Captured on a Remidio smartphone fundus camera. Retinal fundus photograph. 1659x2212.
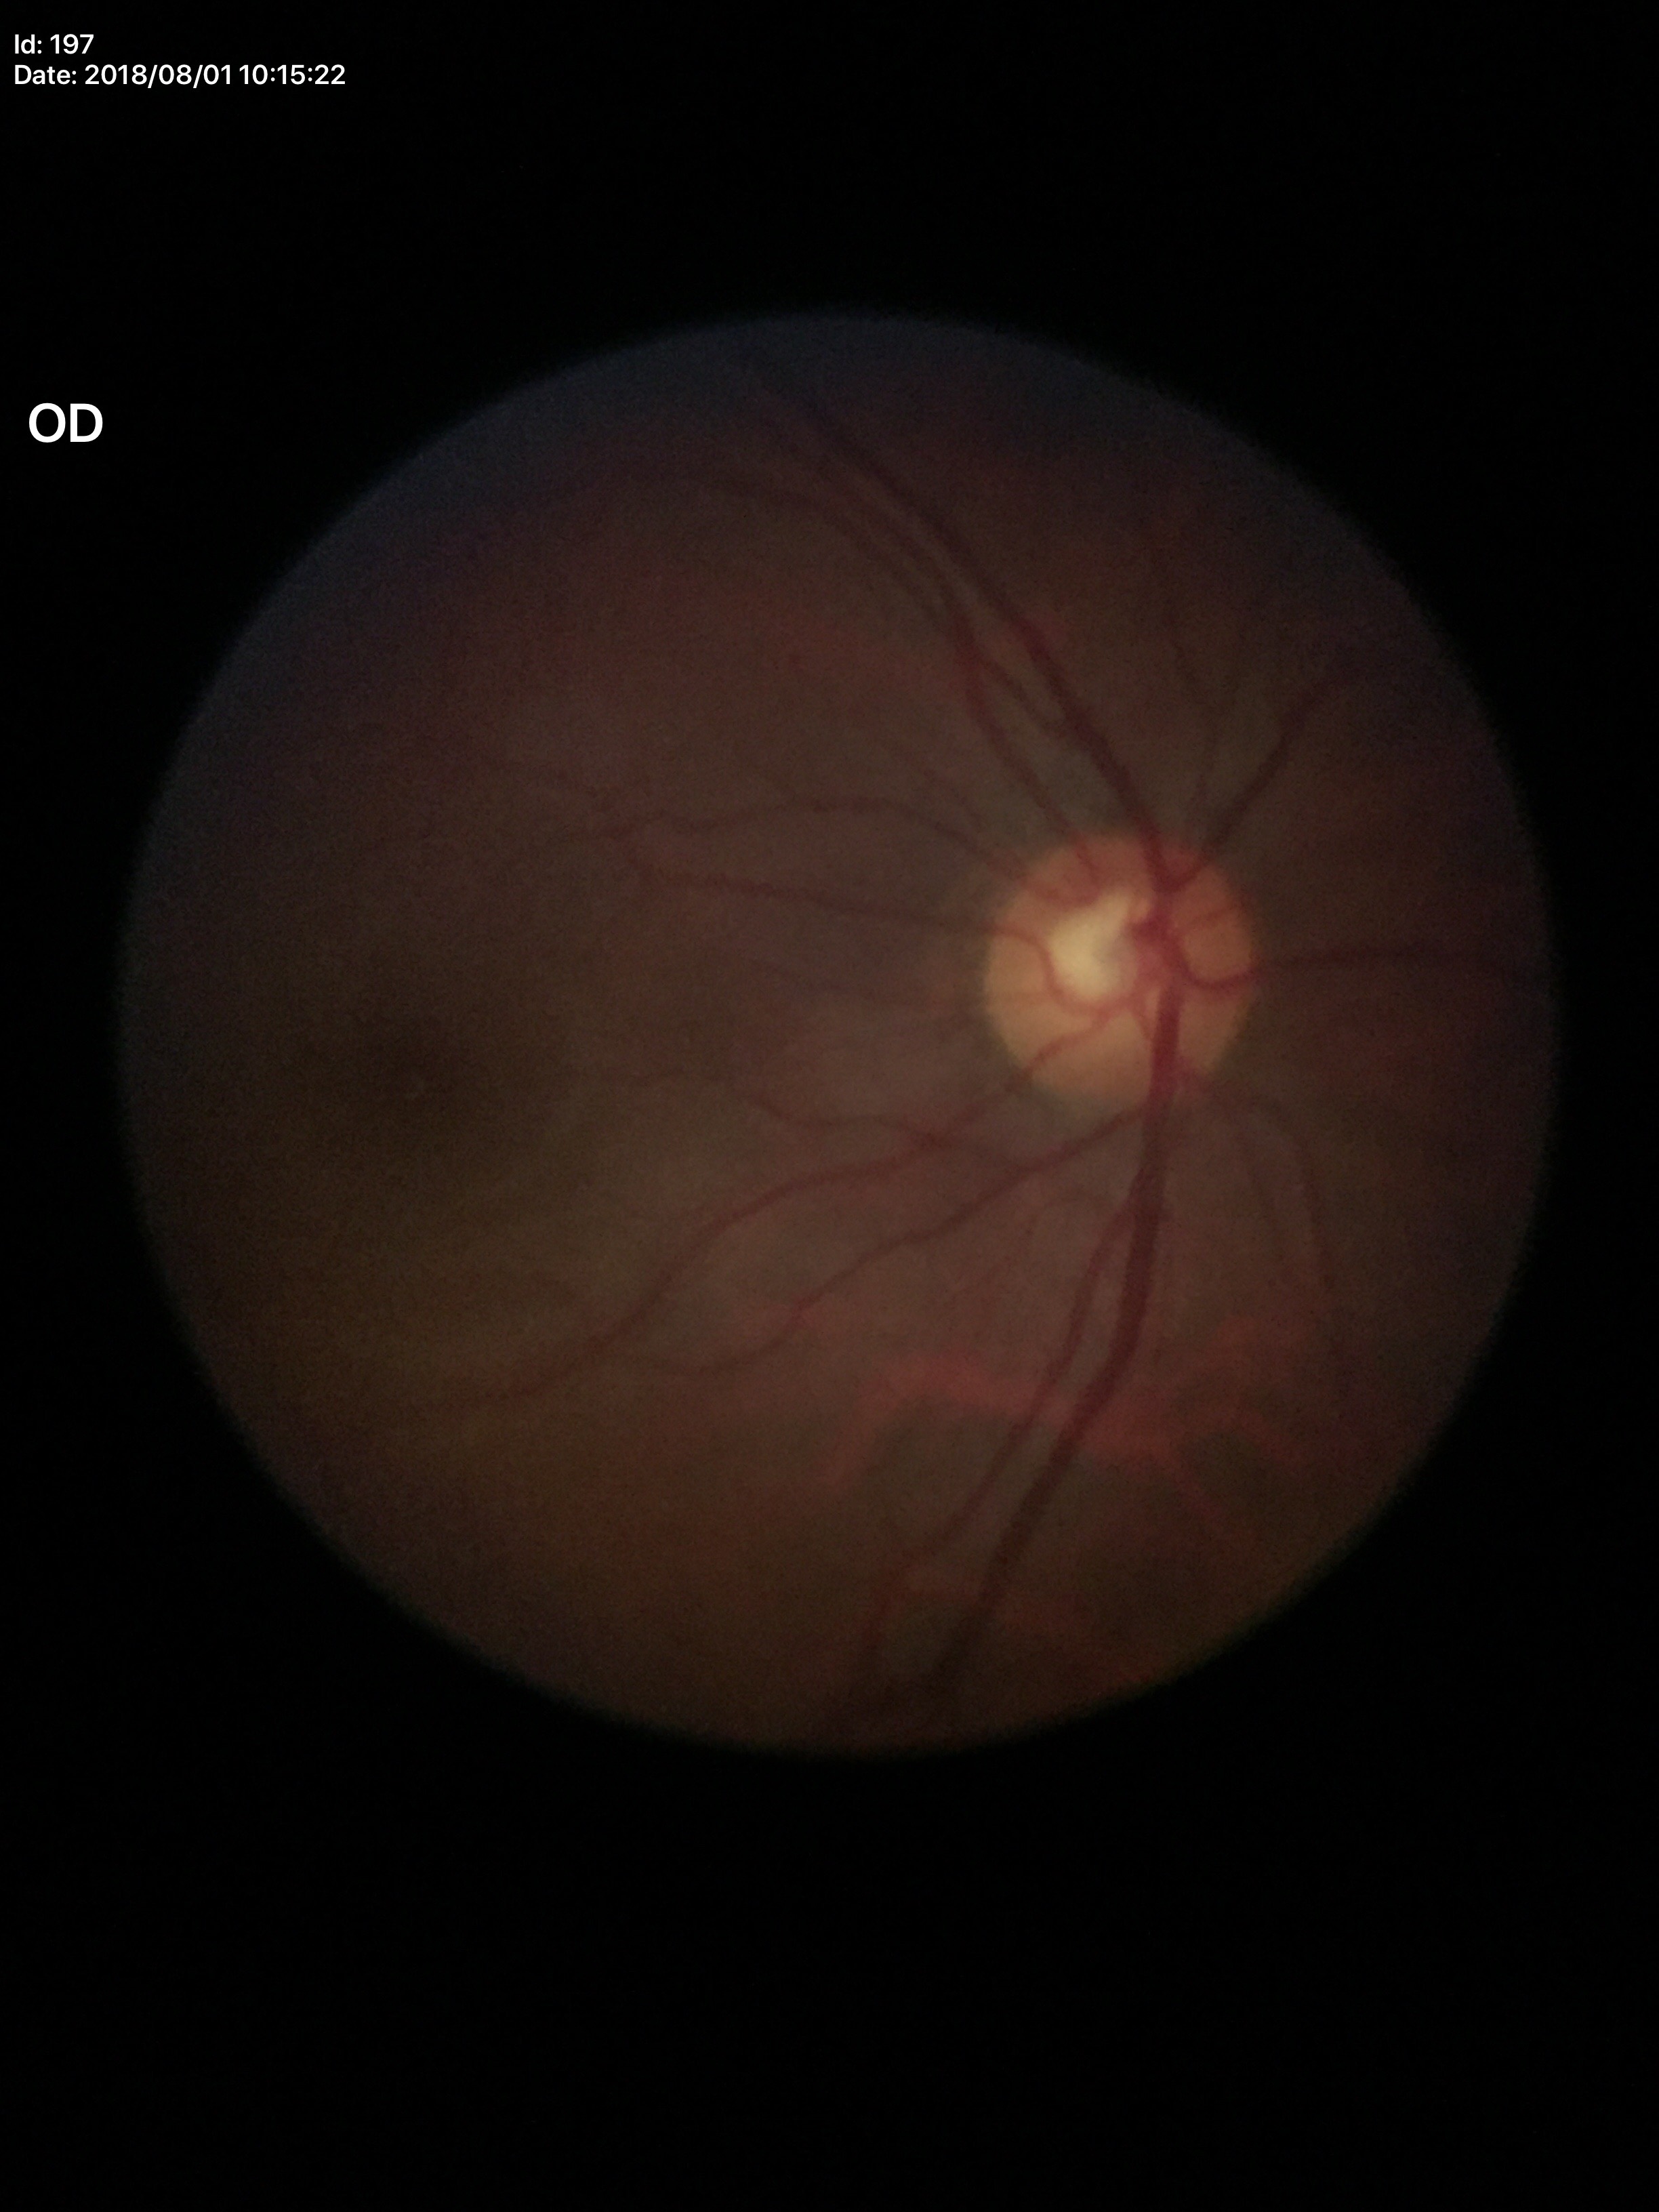
Glaucoma screening: not suspect
vertical CDR: 0.53